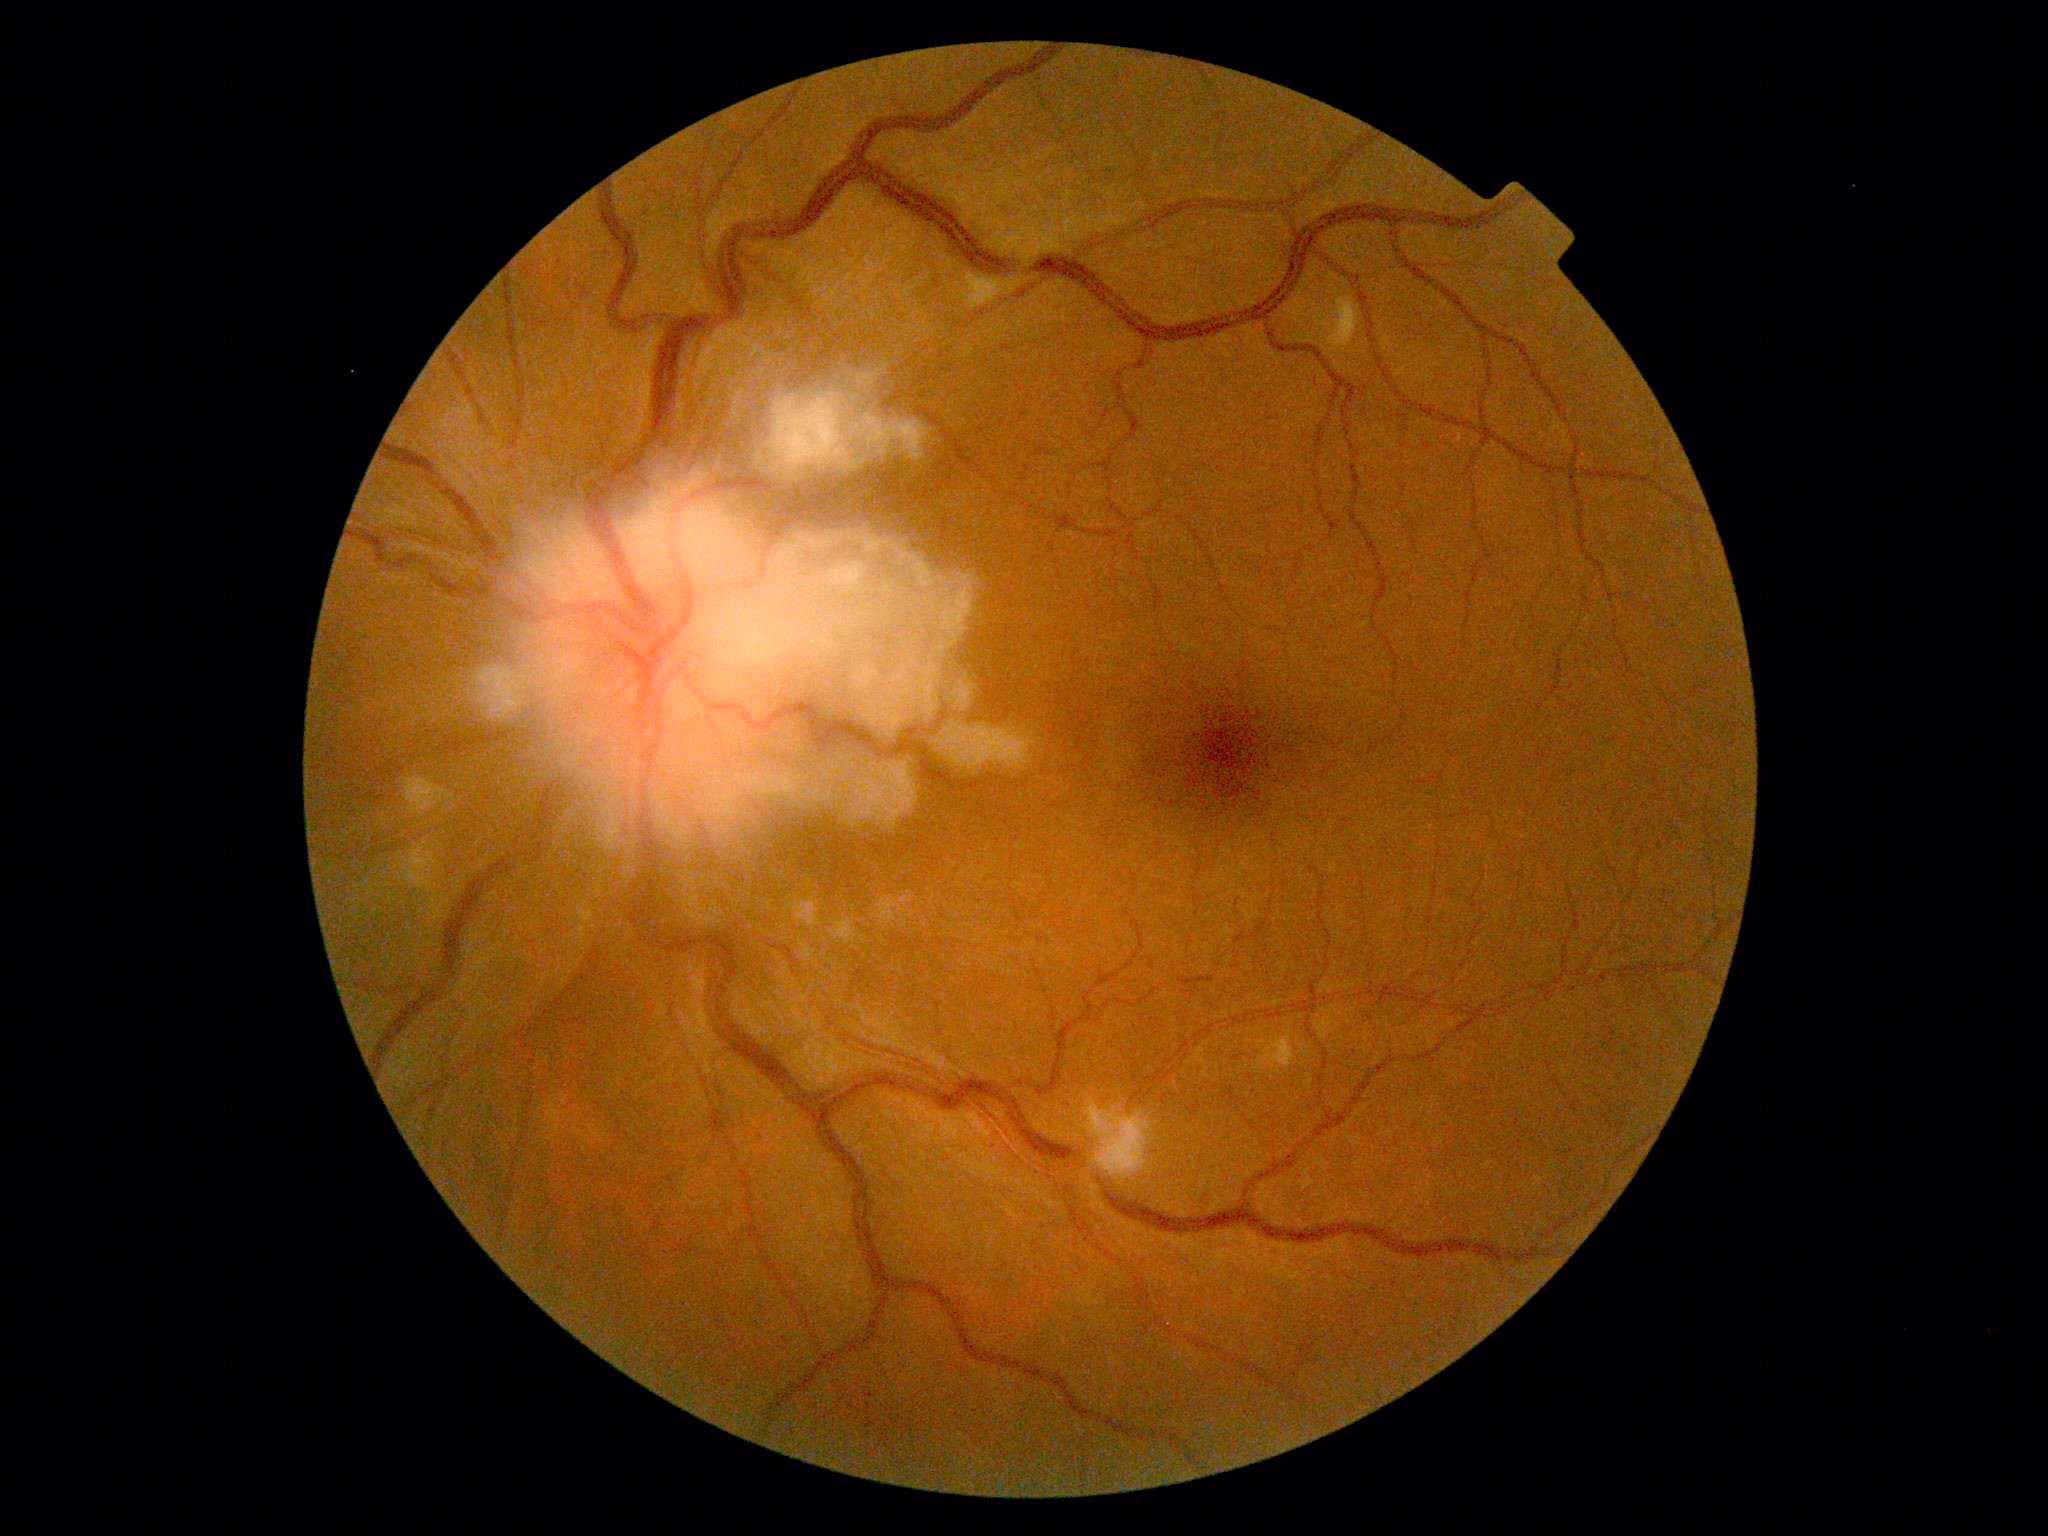
DR grade is 2 — more than just microaneurysms but less than severe NPDR.